Color fundus image · 2228x1652 · dilated-pupil acquisition: 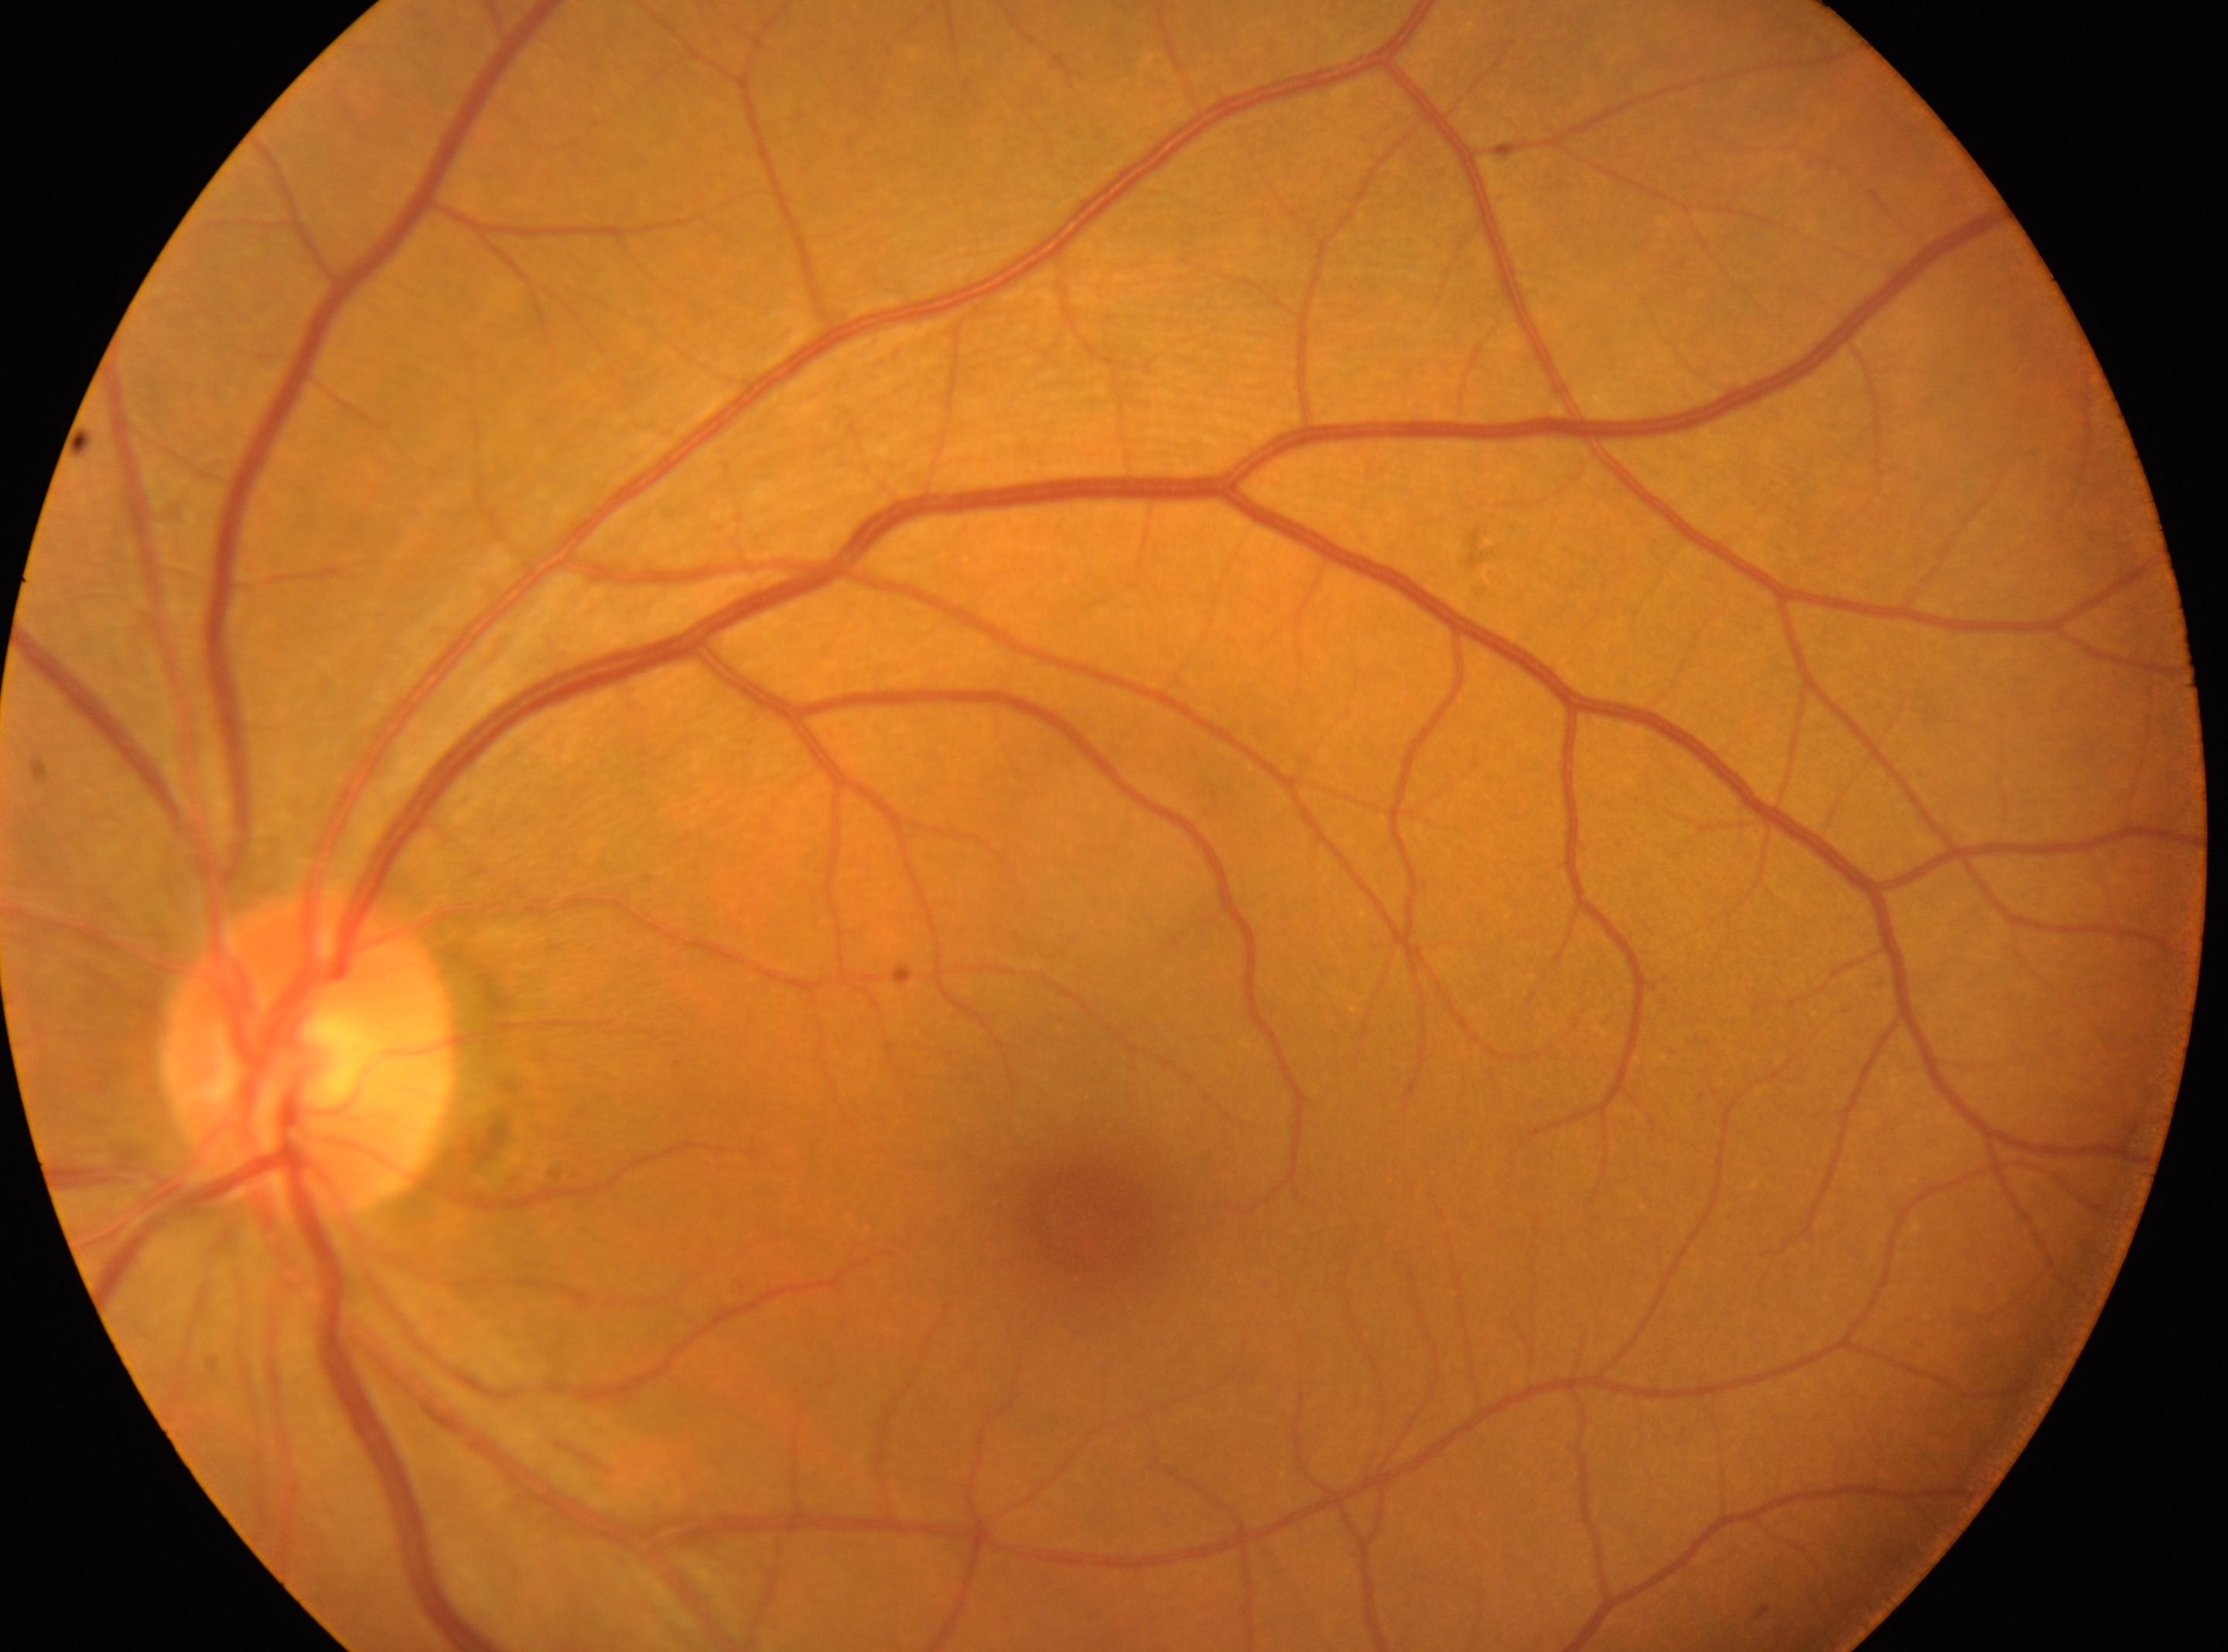
Macular center located at (1080, 1220). DR stage is grade 0 (no apparent retinopathy). This is the left eye. Optic disc center located at (310, 1056).